Wide-field contact fundus photograph of an infant · Natus RetCam Envision, 130° FOV — 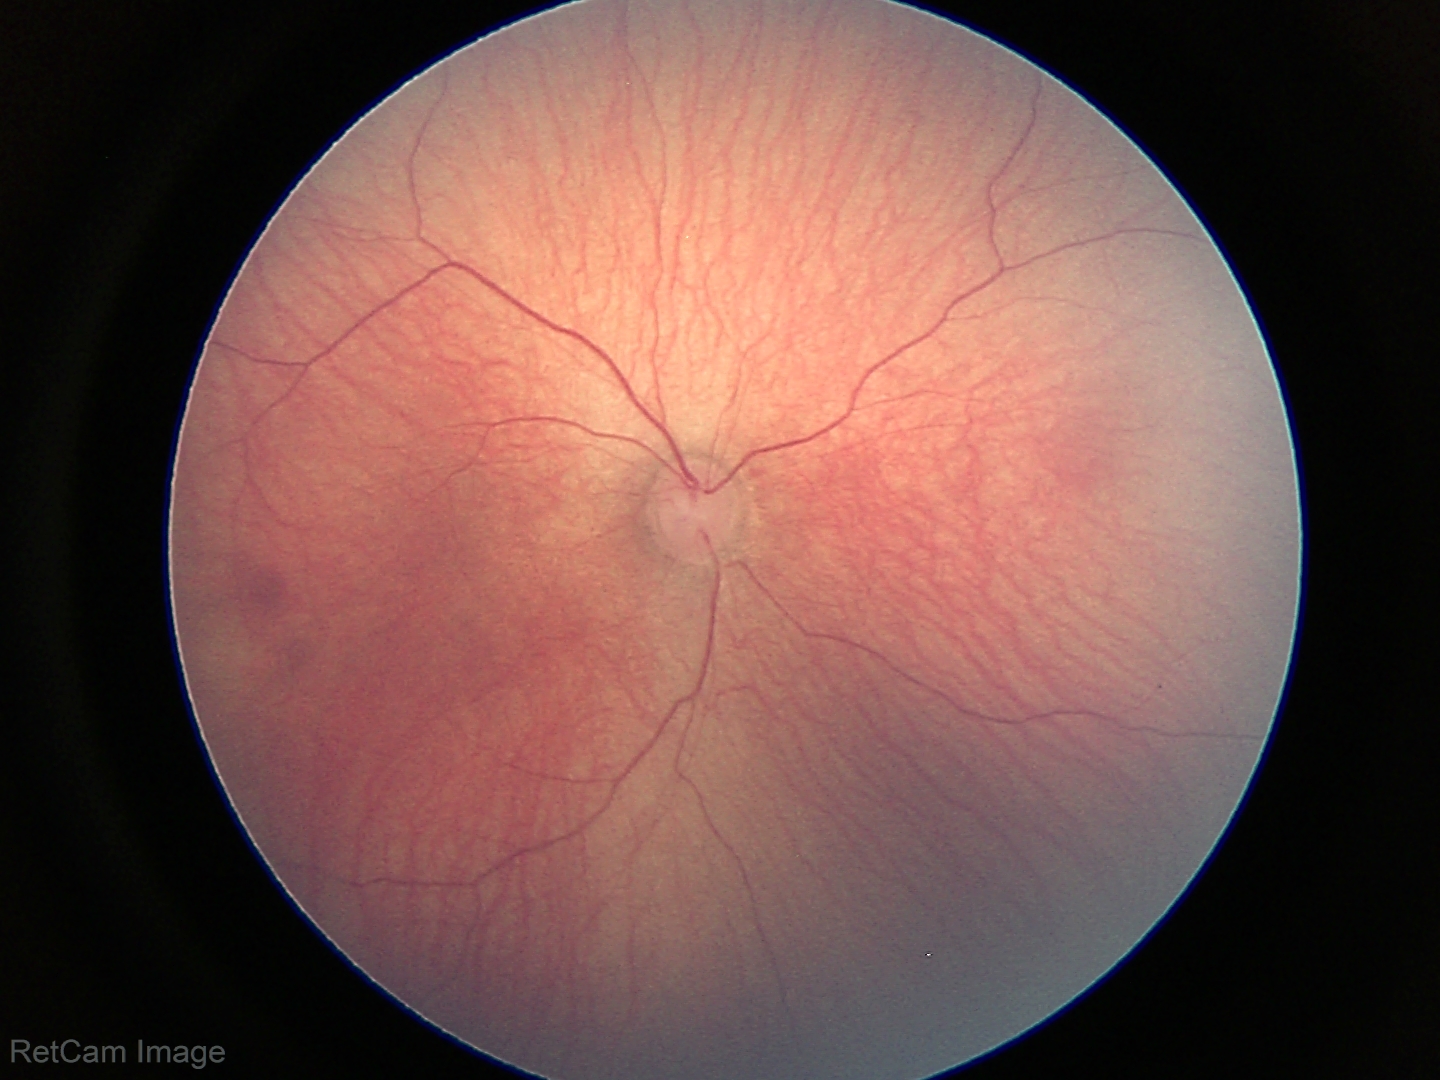

Examination with physiological retinal findings.